Diabetic retinopathy graded by the modified Davis classification:
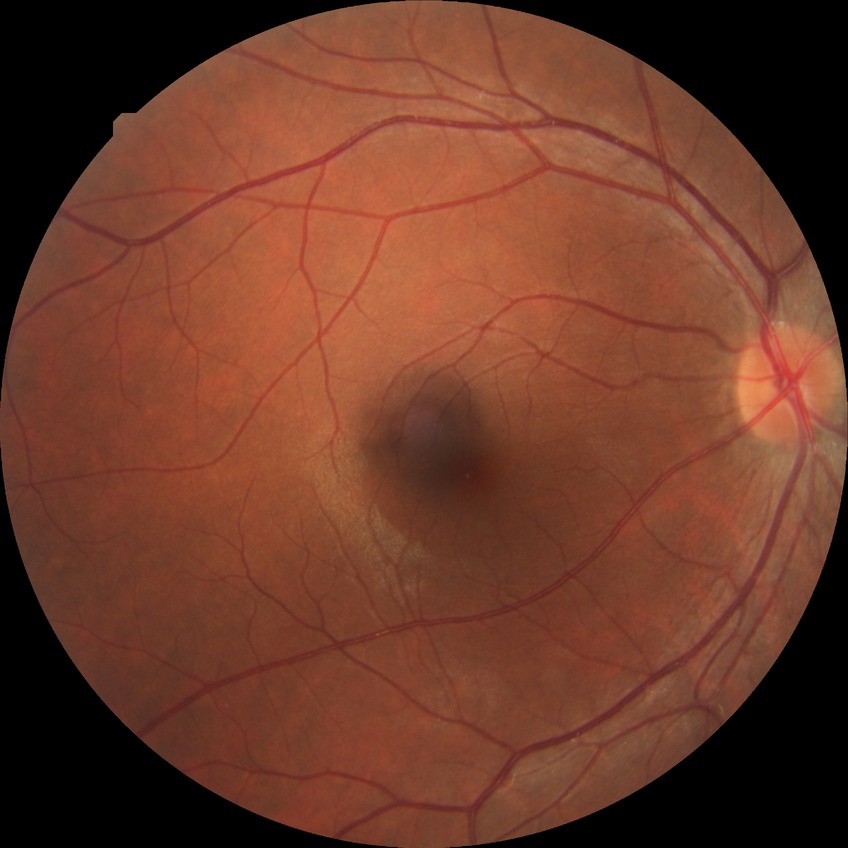
Diabetic retinopathy (DR): no diabetic retinopathy (NDR).